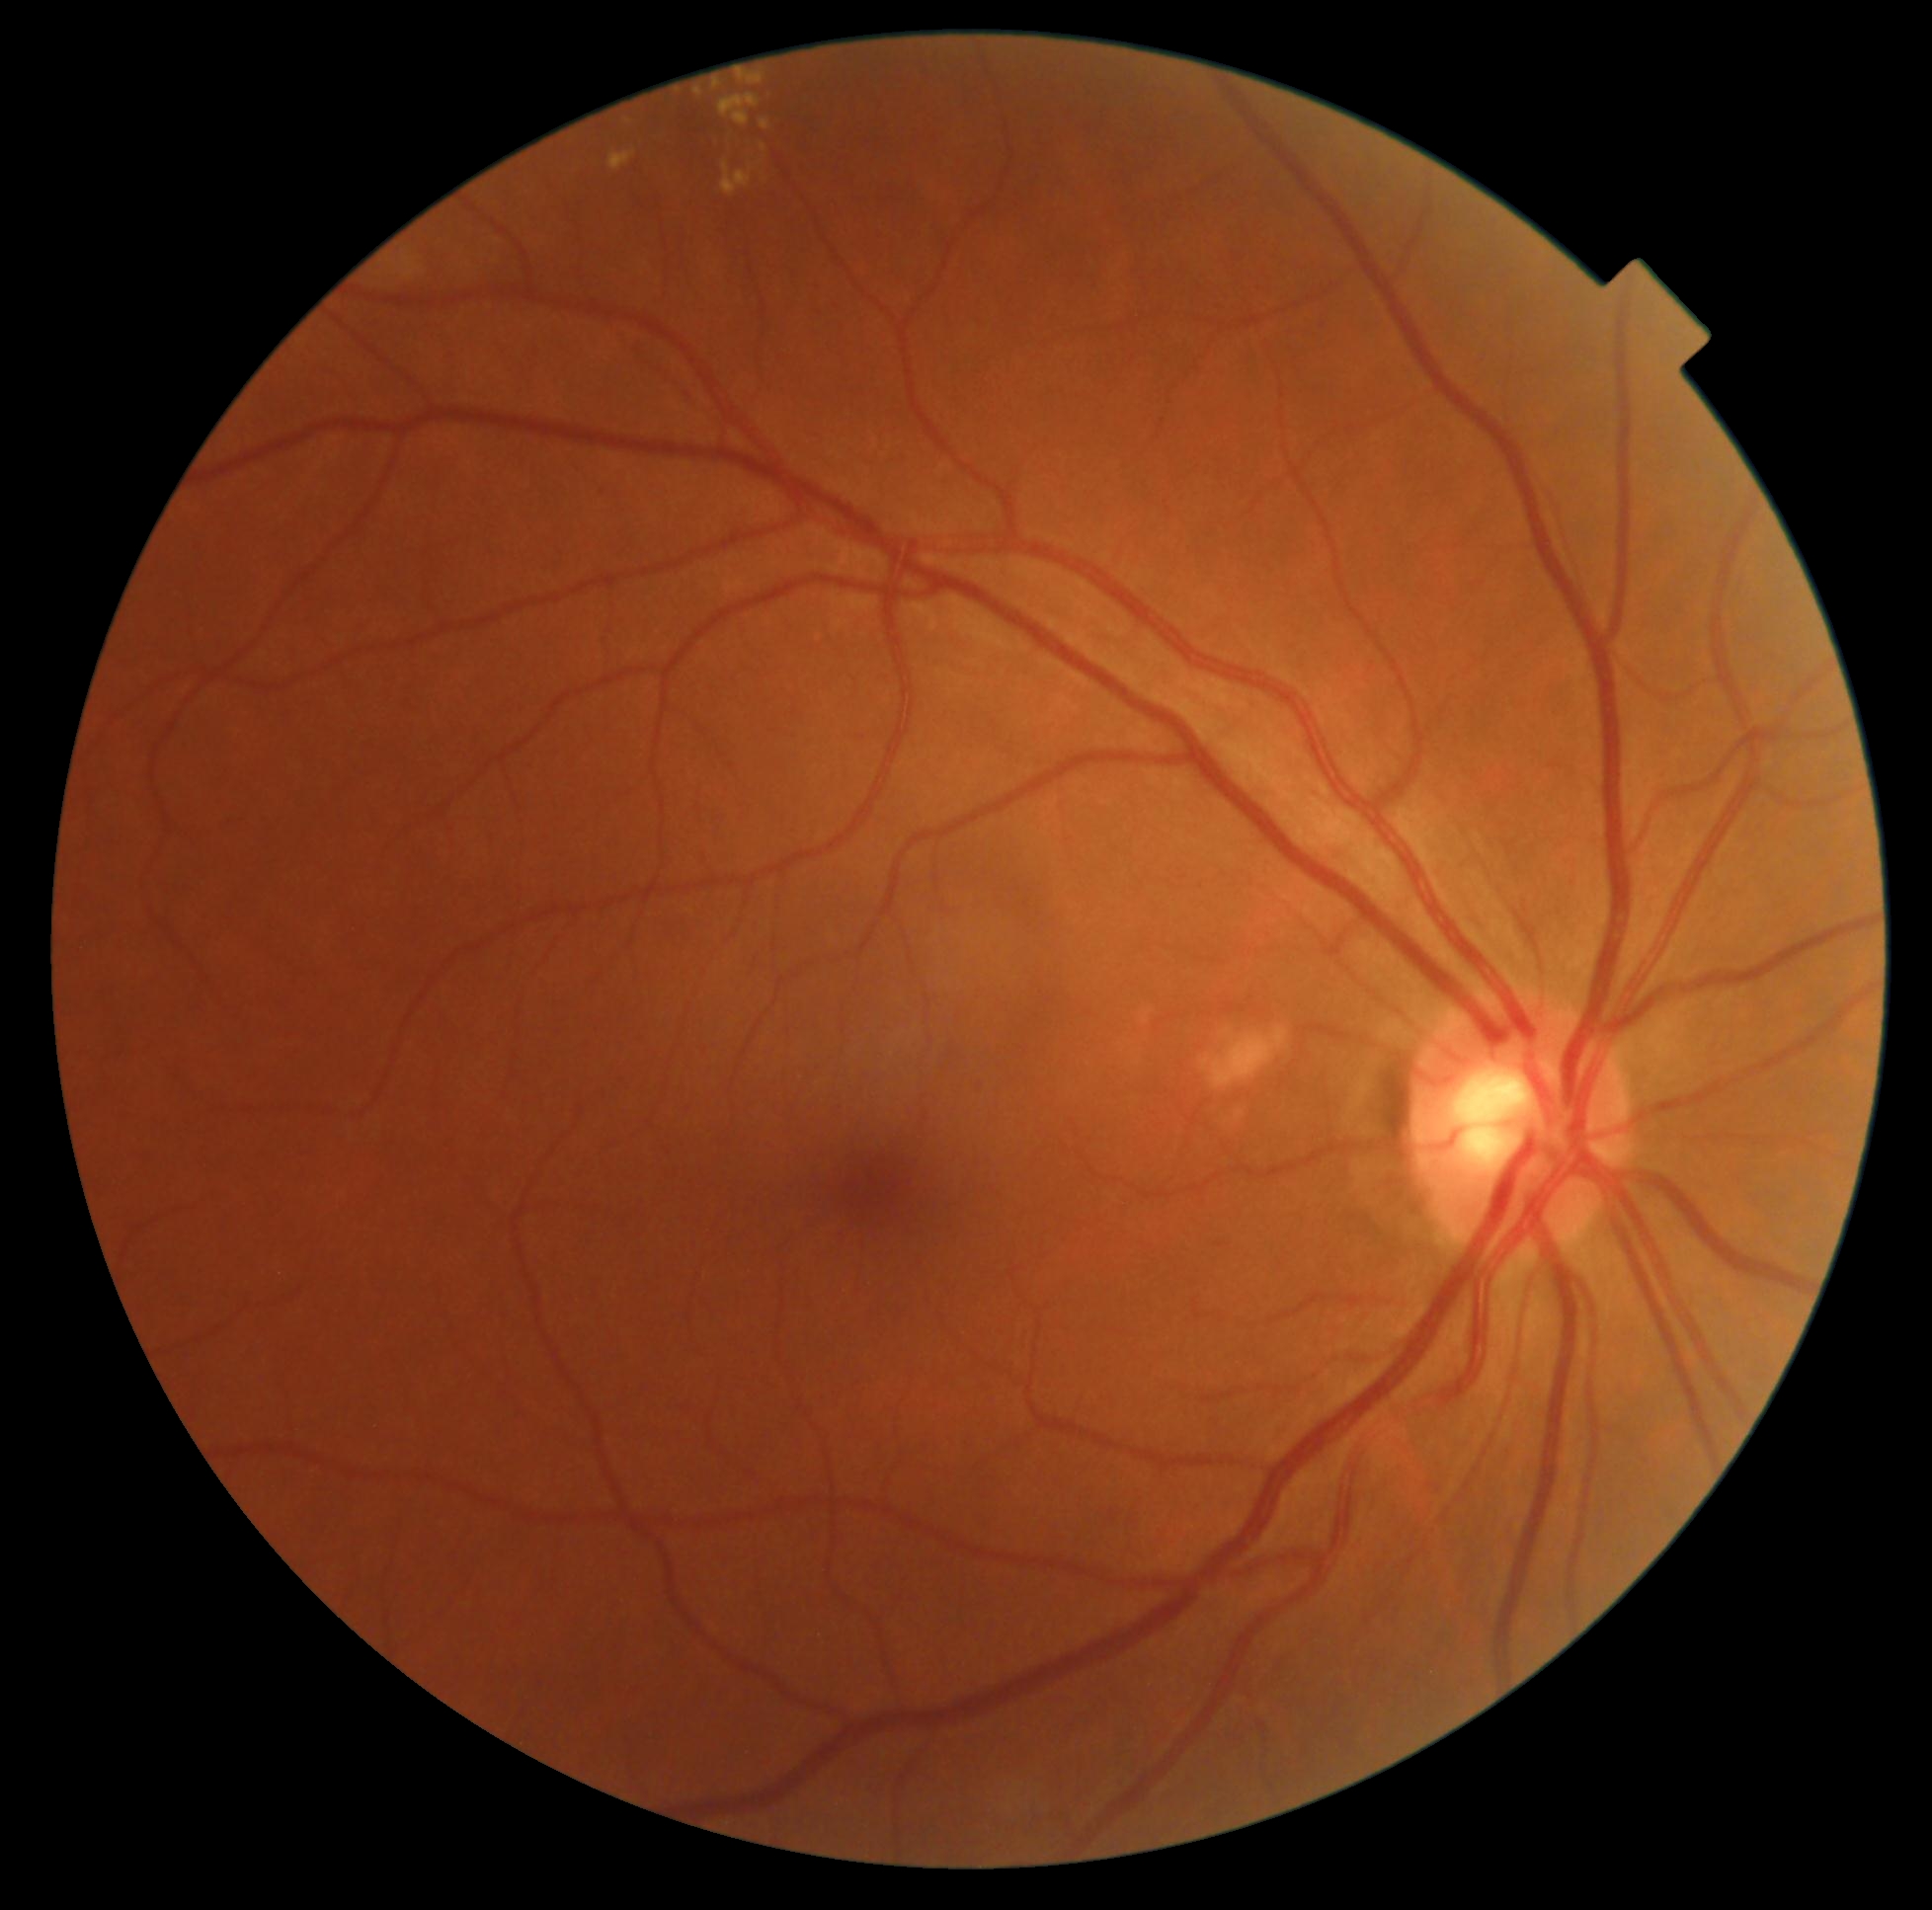 DR grade: moderate non-proliferative diabetic retinopathy (2).